Pediatric wide-field fundus photograph · 640x480px — 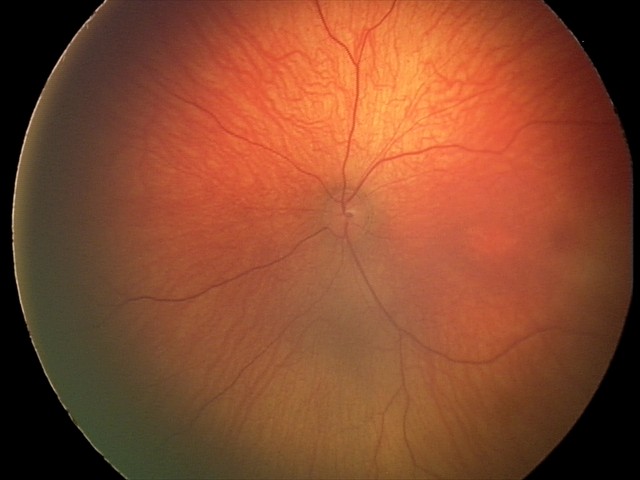 Normal screening examination.